Wide-field fundus image from infant ROP screening — 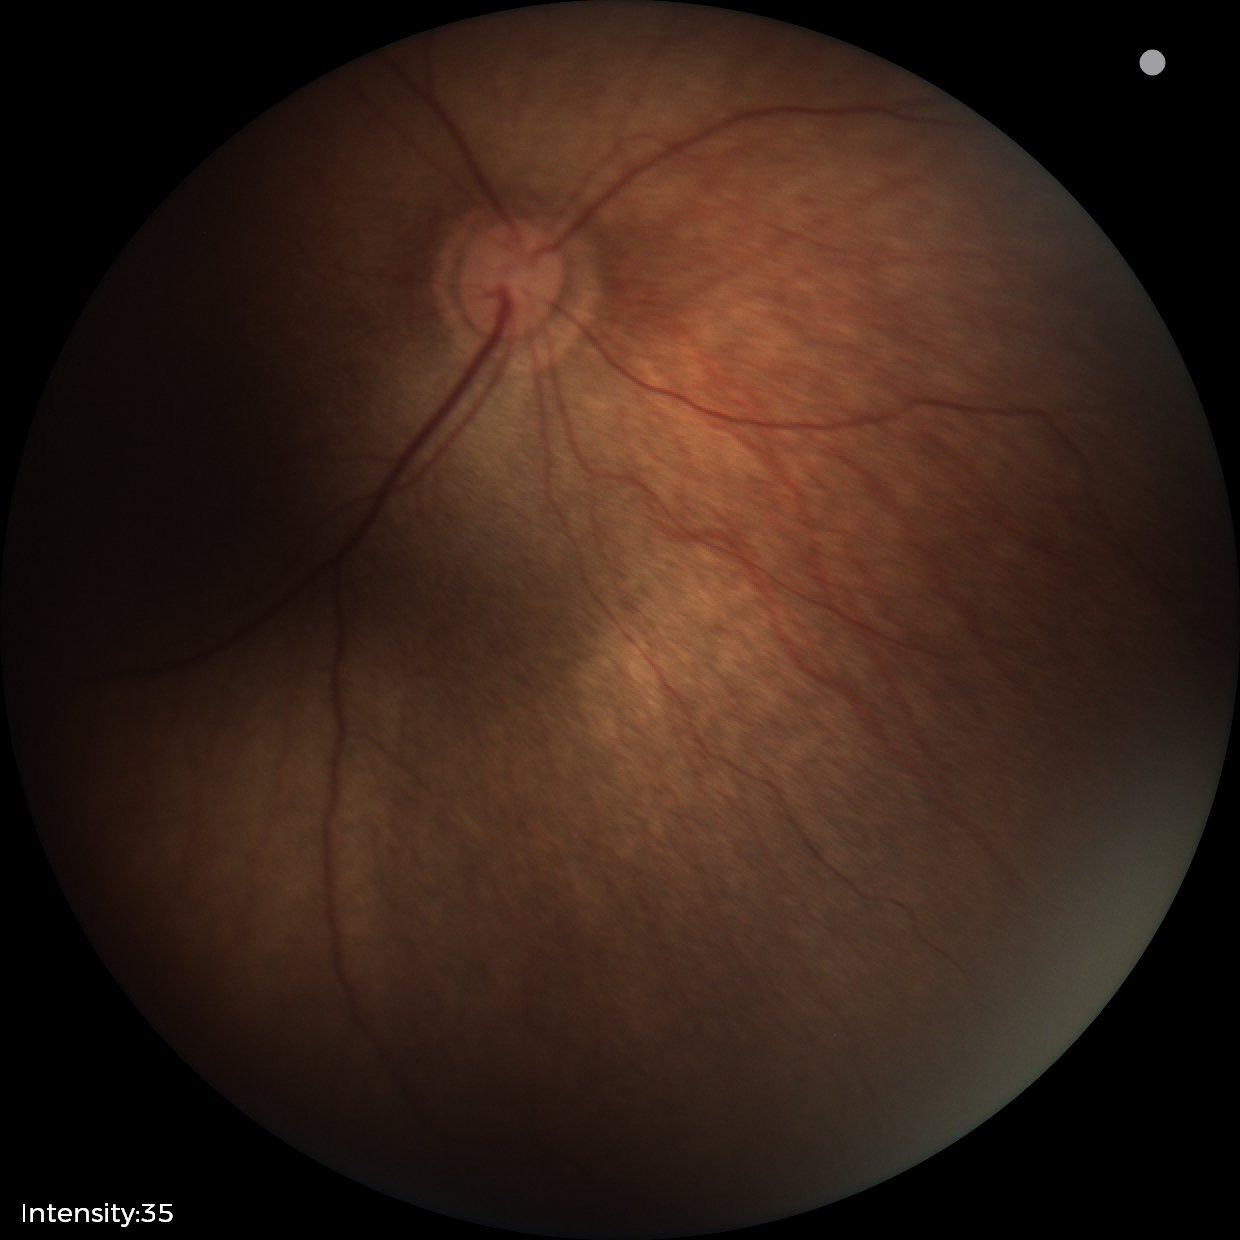

Physiological retinal appearance for postconceptual age.